130° field of view (Natus RetCam Envision) · infant wide-field retinal image · image size 1440x1080
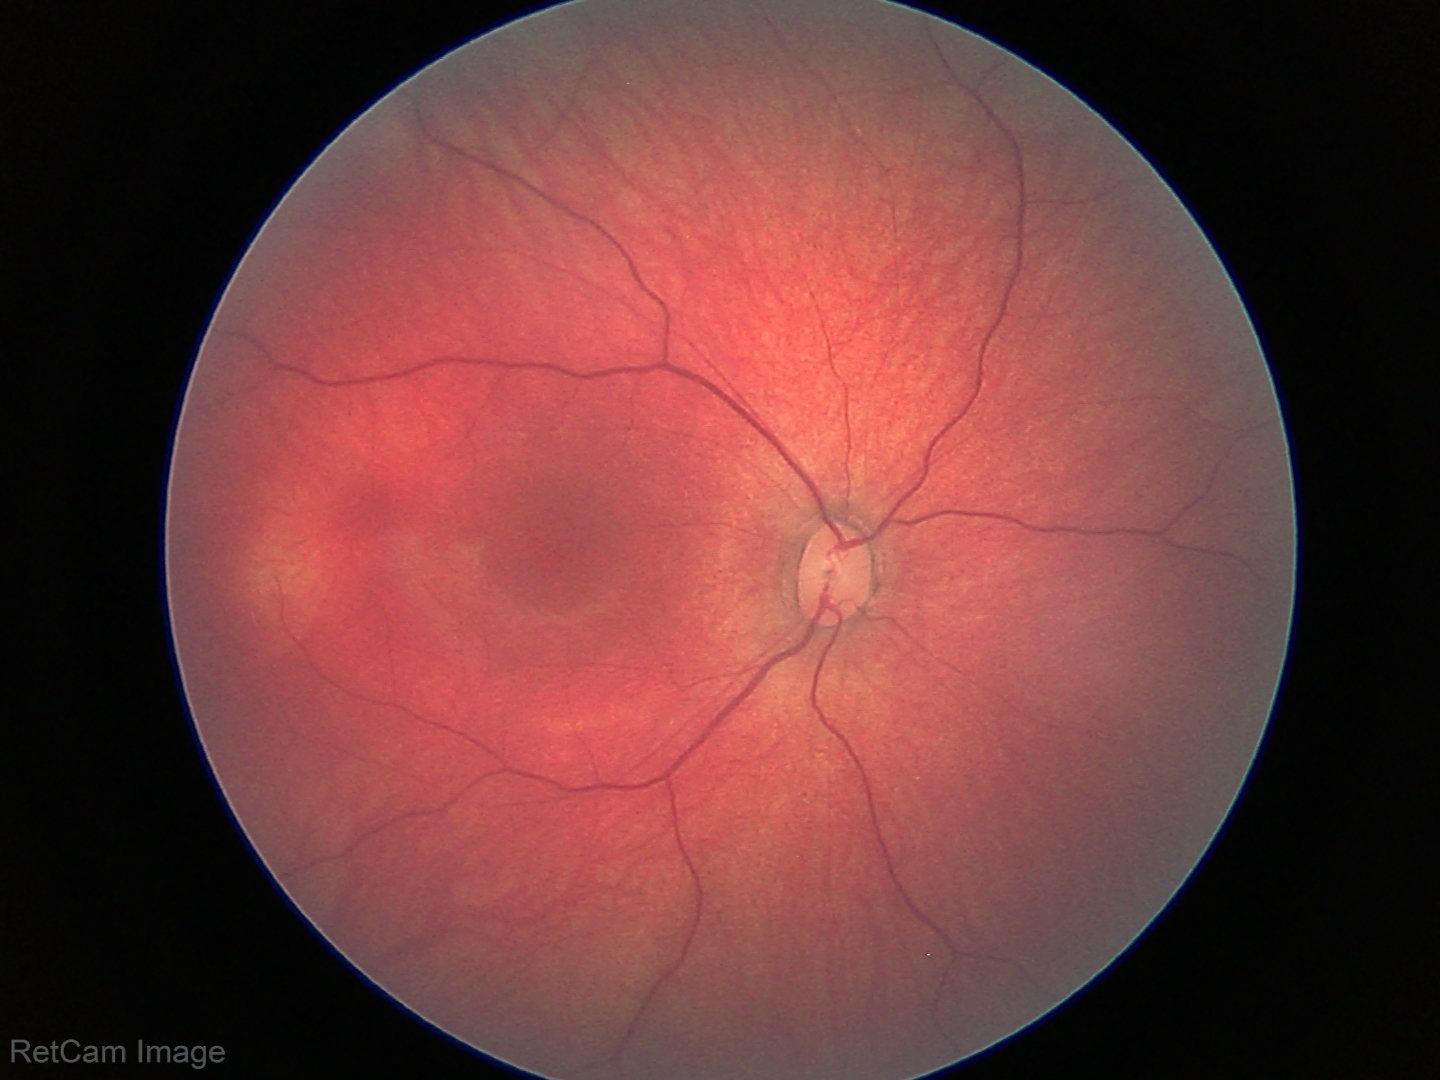 Q: What was the screening finding?
A: no abnormal retinal findings